Posterior pole photograph, nonmydriatic fundus photograph, NIDEK AFC-230 fundus camera, graded on the modified Davis scale, 848 x 848 pixels, 45° field of view
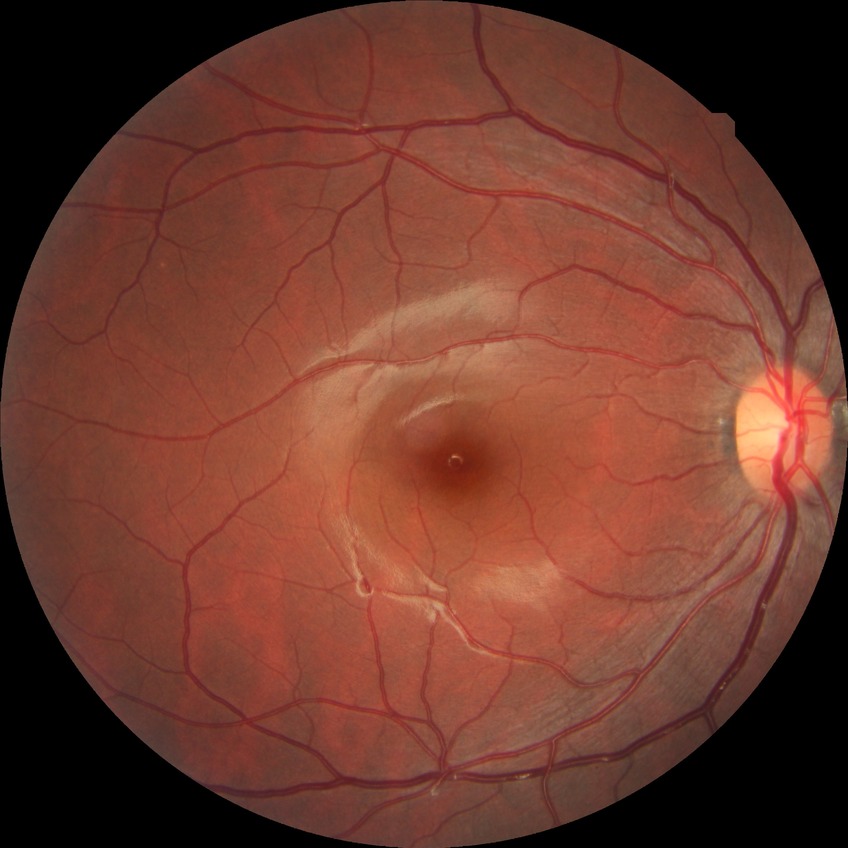 diabetic retinopathy (DR): NDR (no diabetic retinopathy).